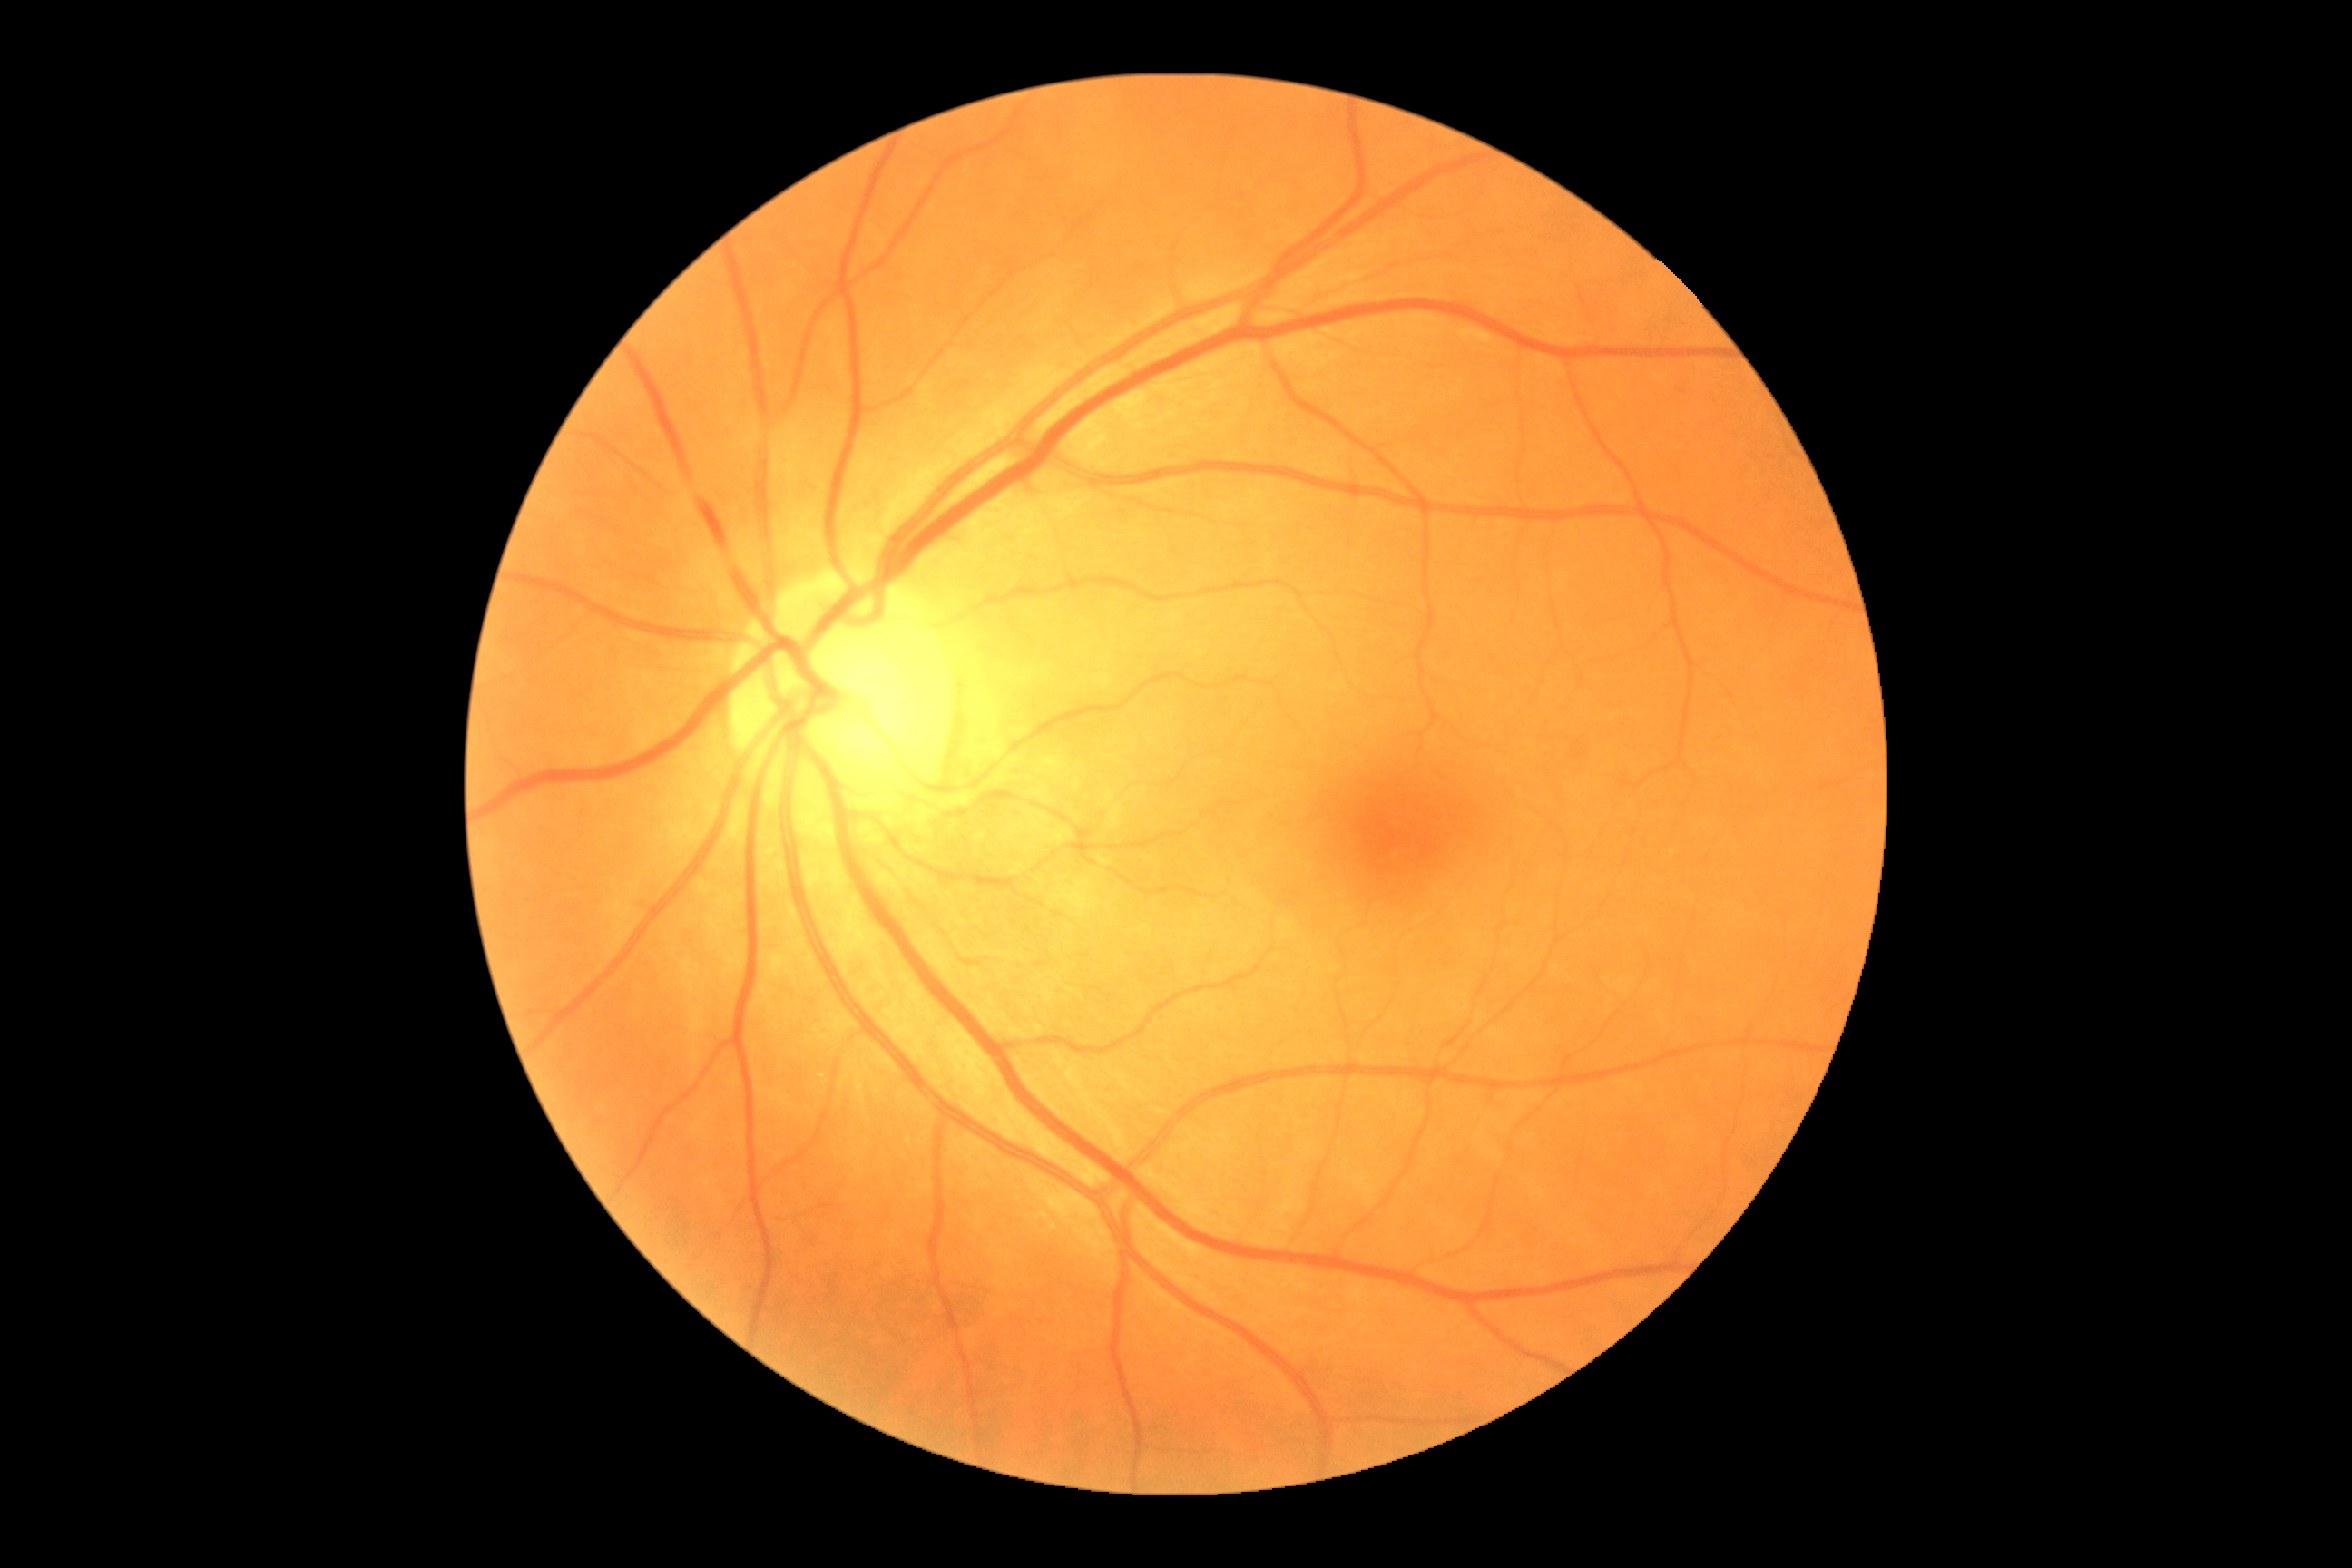

DR stage is grade 0.